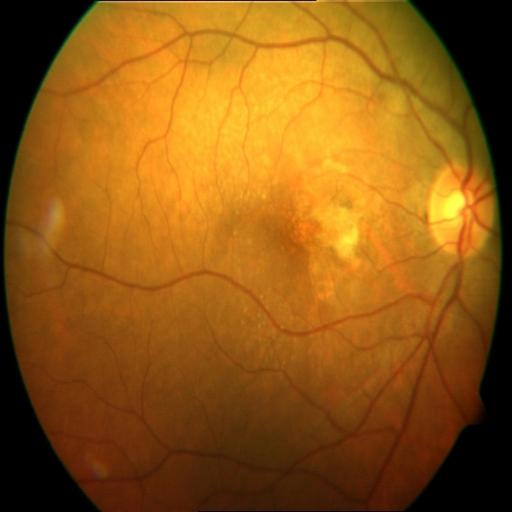

This fundus photograph shows chorioretinitis.